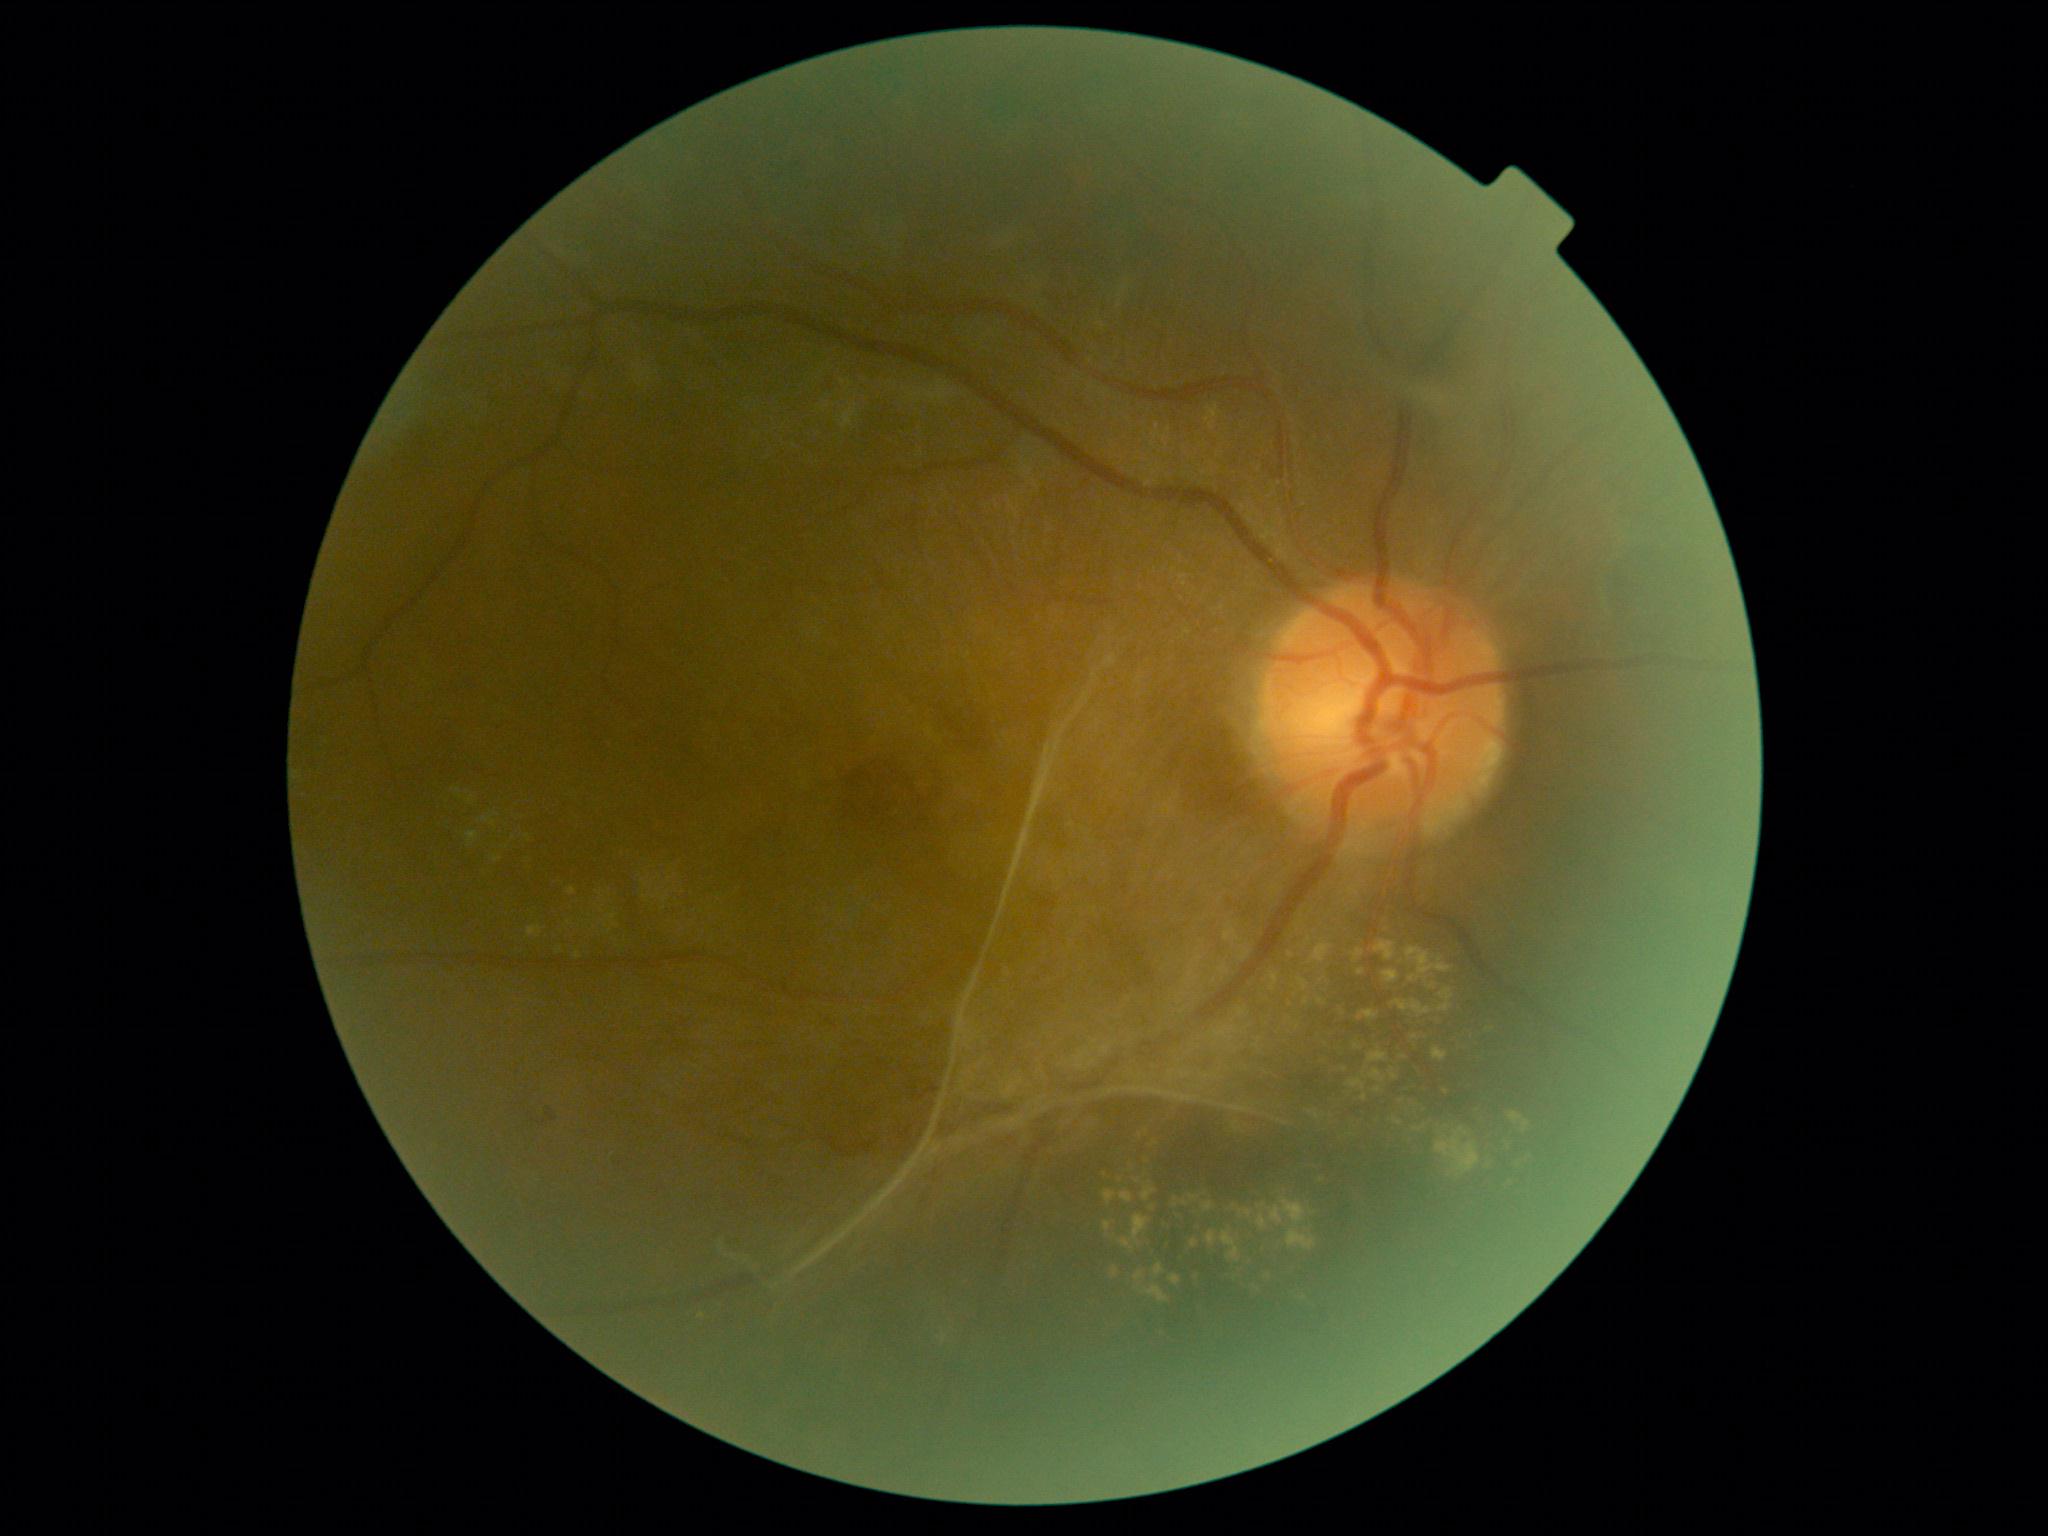 Diabetic retinopathy (DR): PDR (grade 4).